Topcon TRC-50DX, 2228 x 1652 pixels.
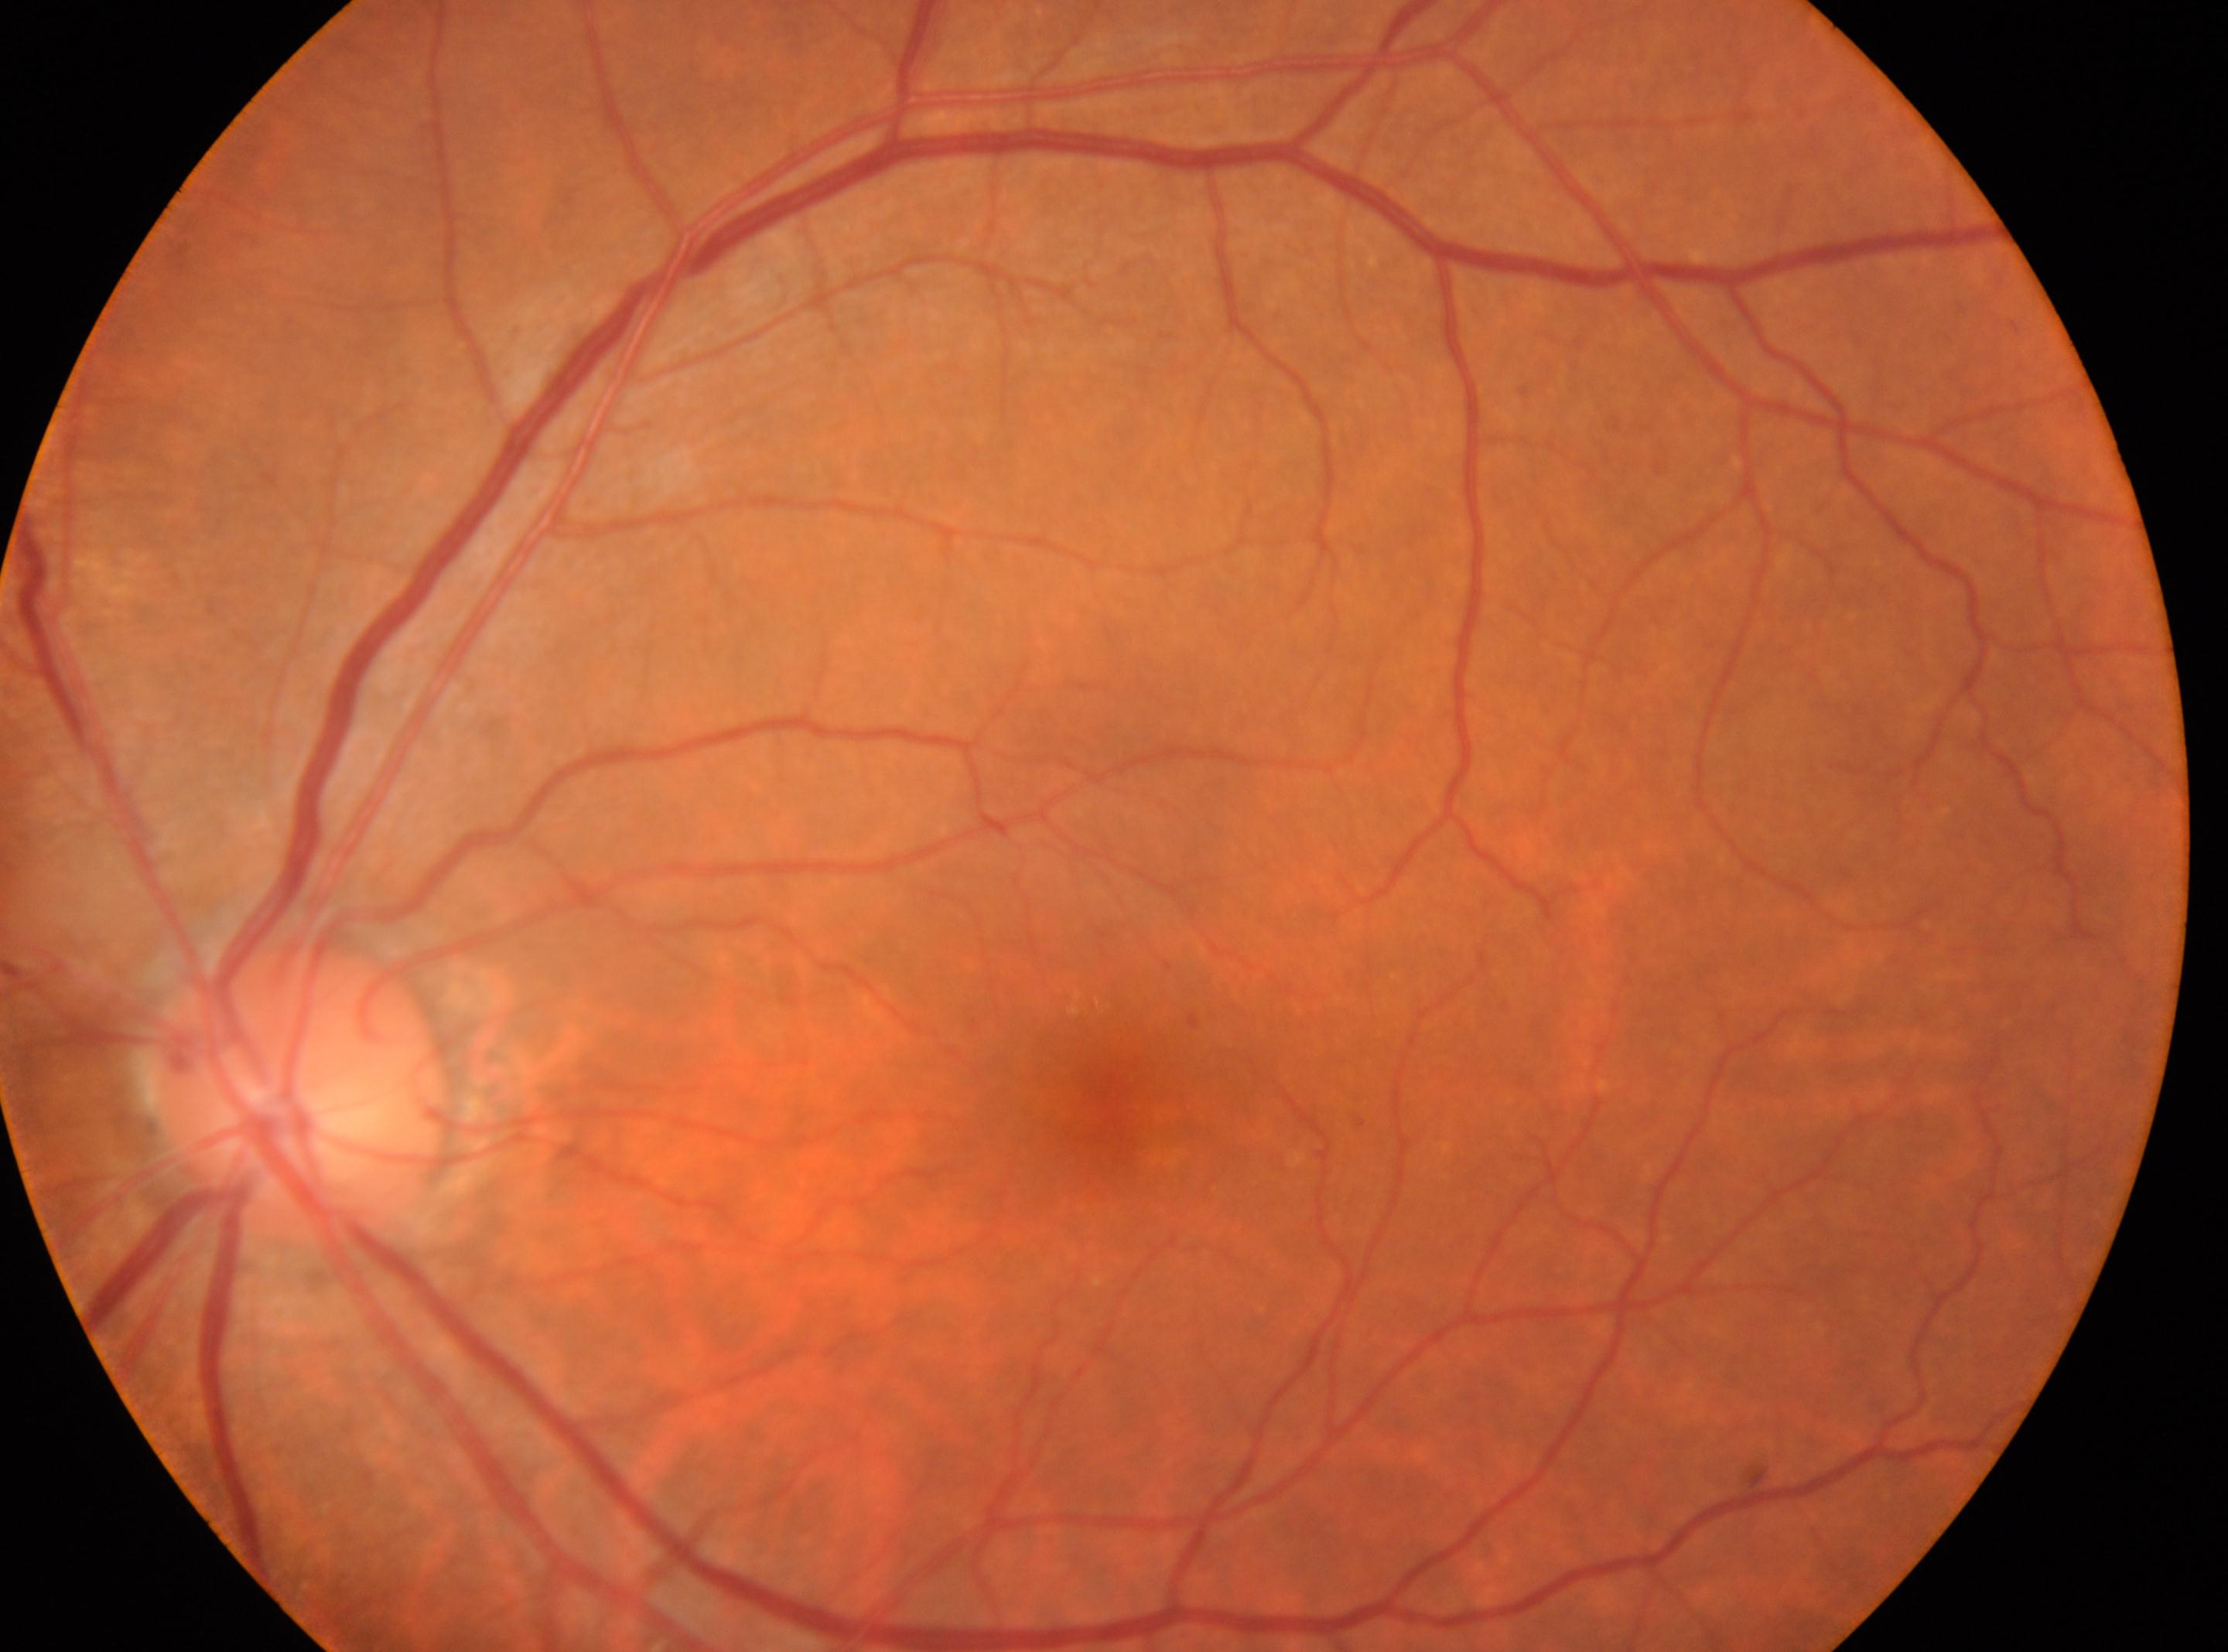
{"dr_category": "non-proliferative diabetic retinopathy", "optic_disc": "(x=298, y=1089)", "eye": "left", "dr_grade": "mild NPDR (1)", "fovea": "(x=1100, y=1097)"}